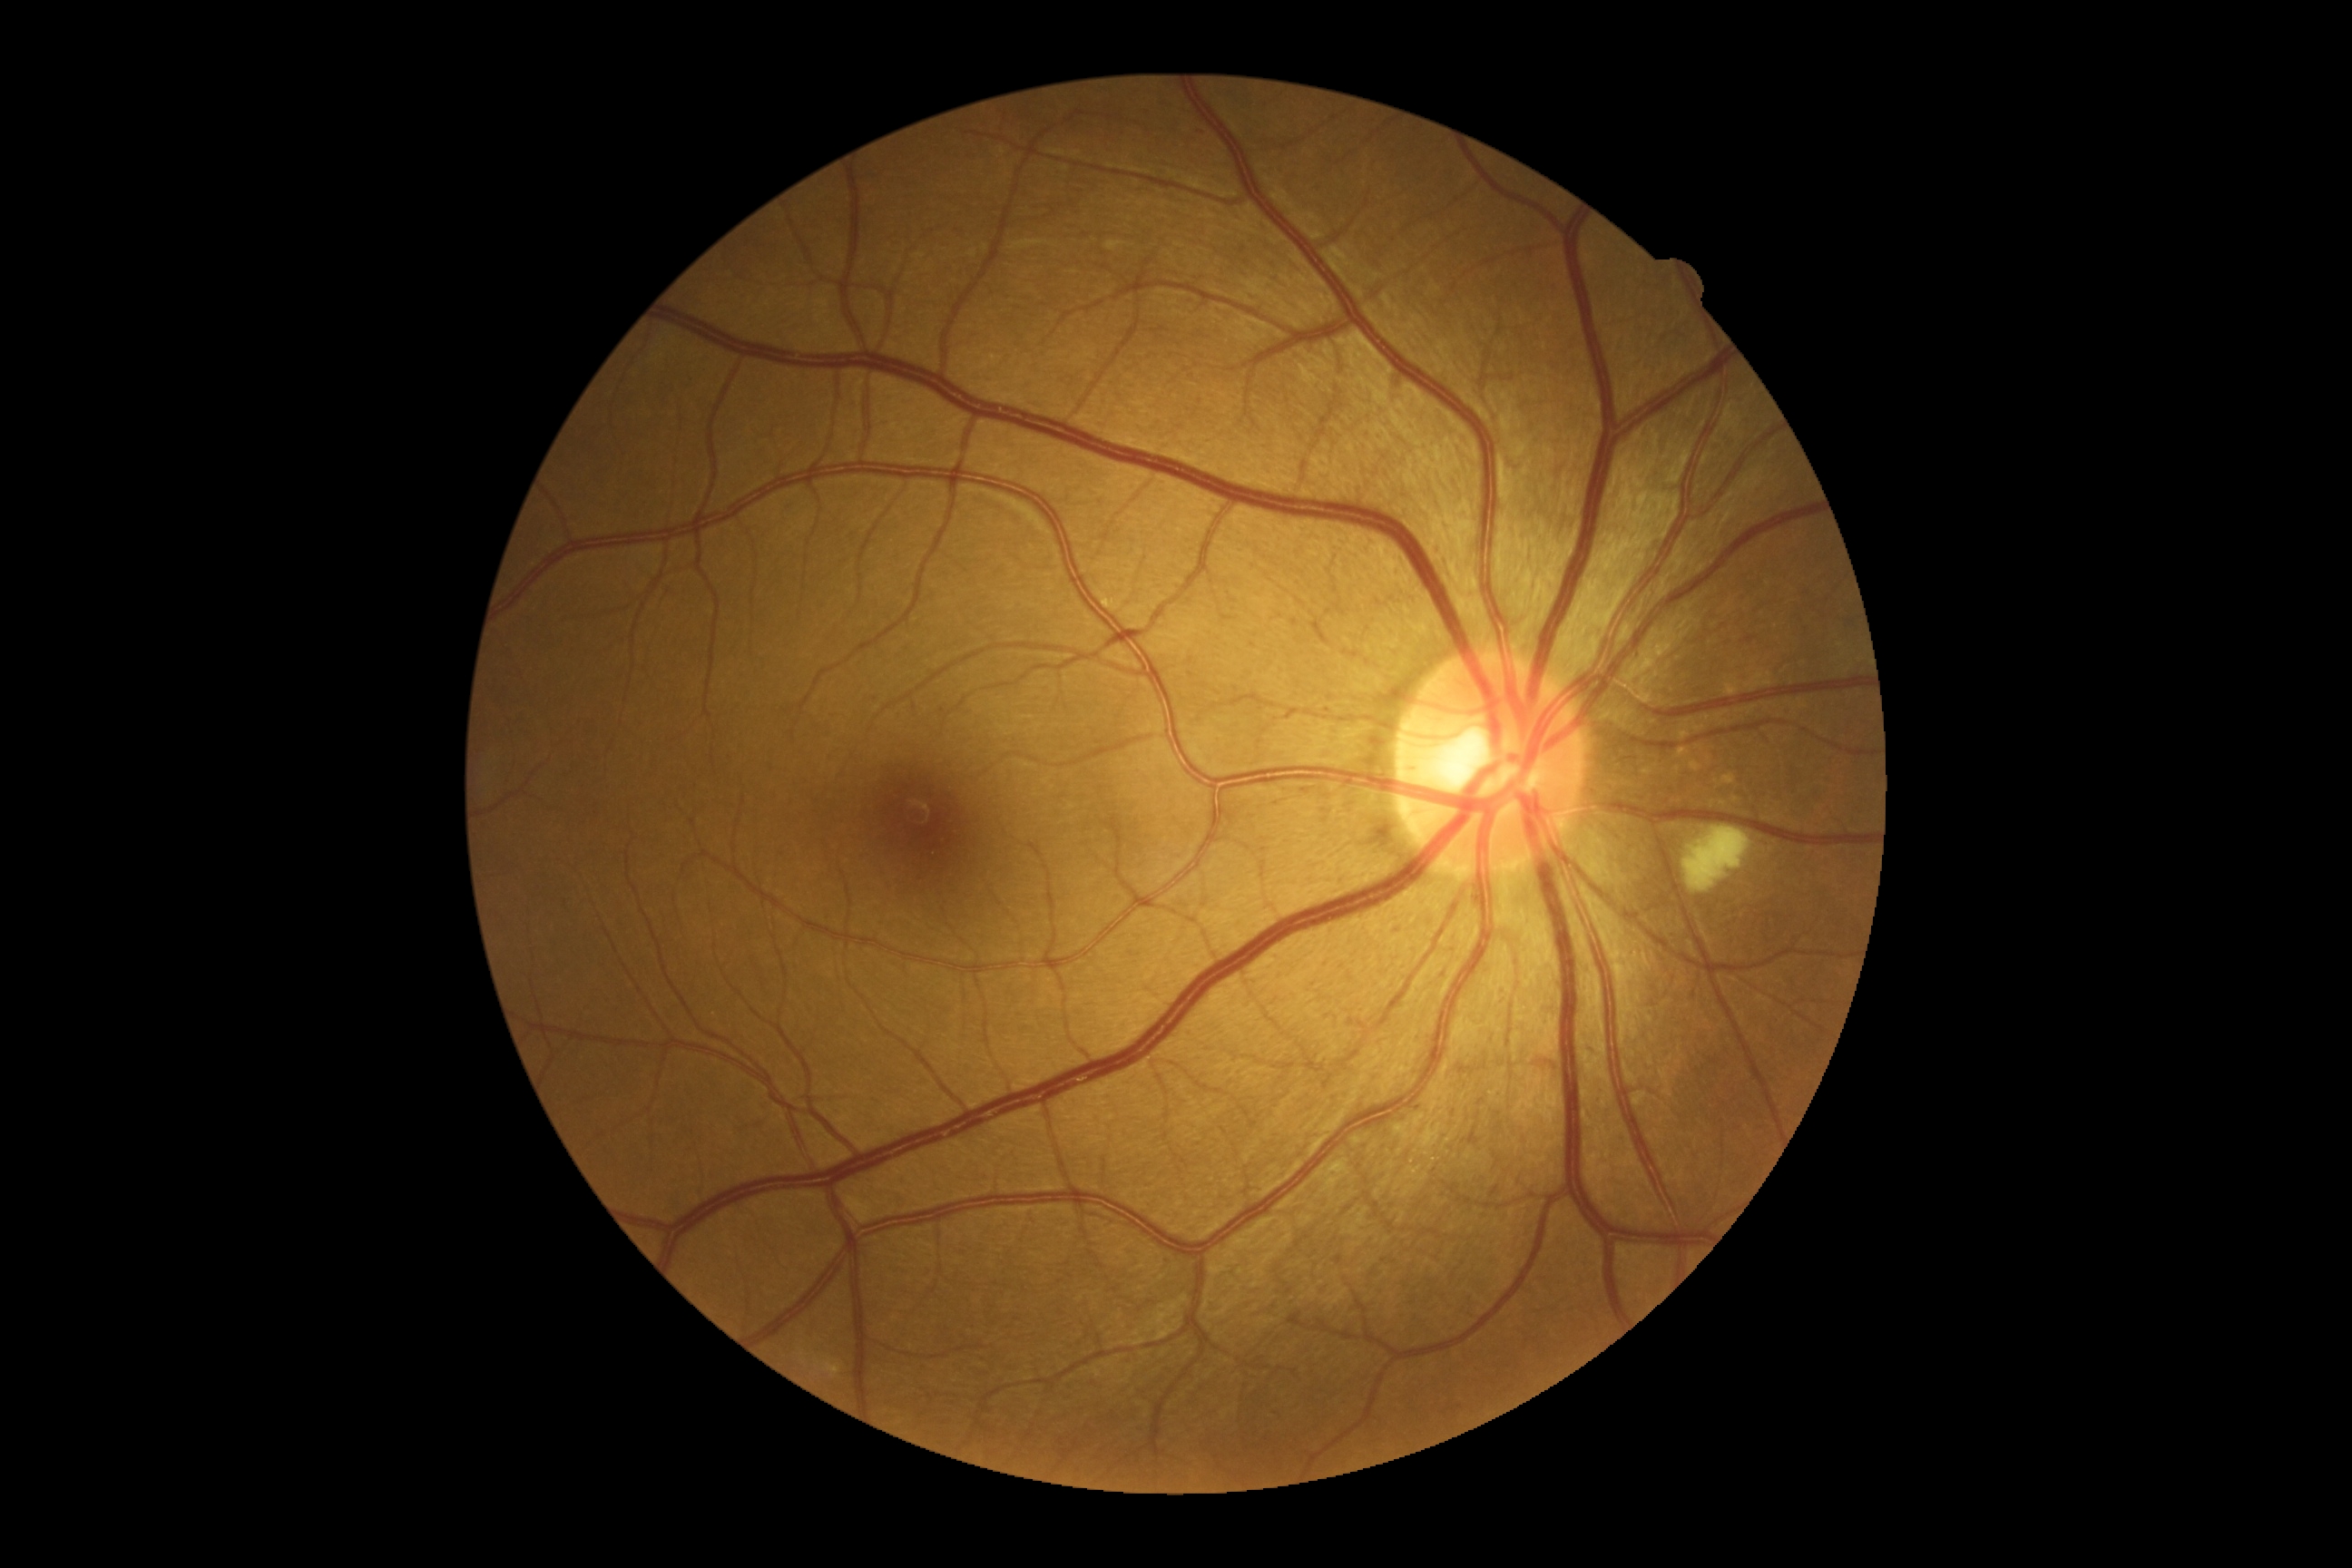

DR: moderate NPDR (grade 2) — more than just microaneurysms but less than severe NPDR.